Fundus photo
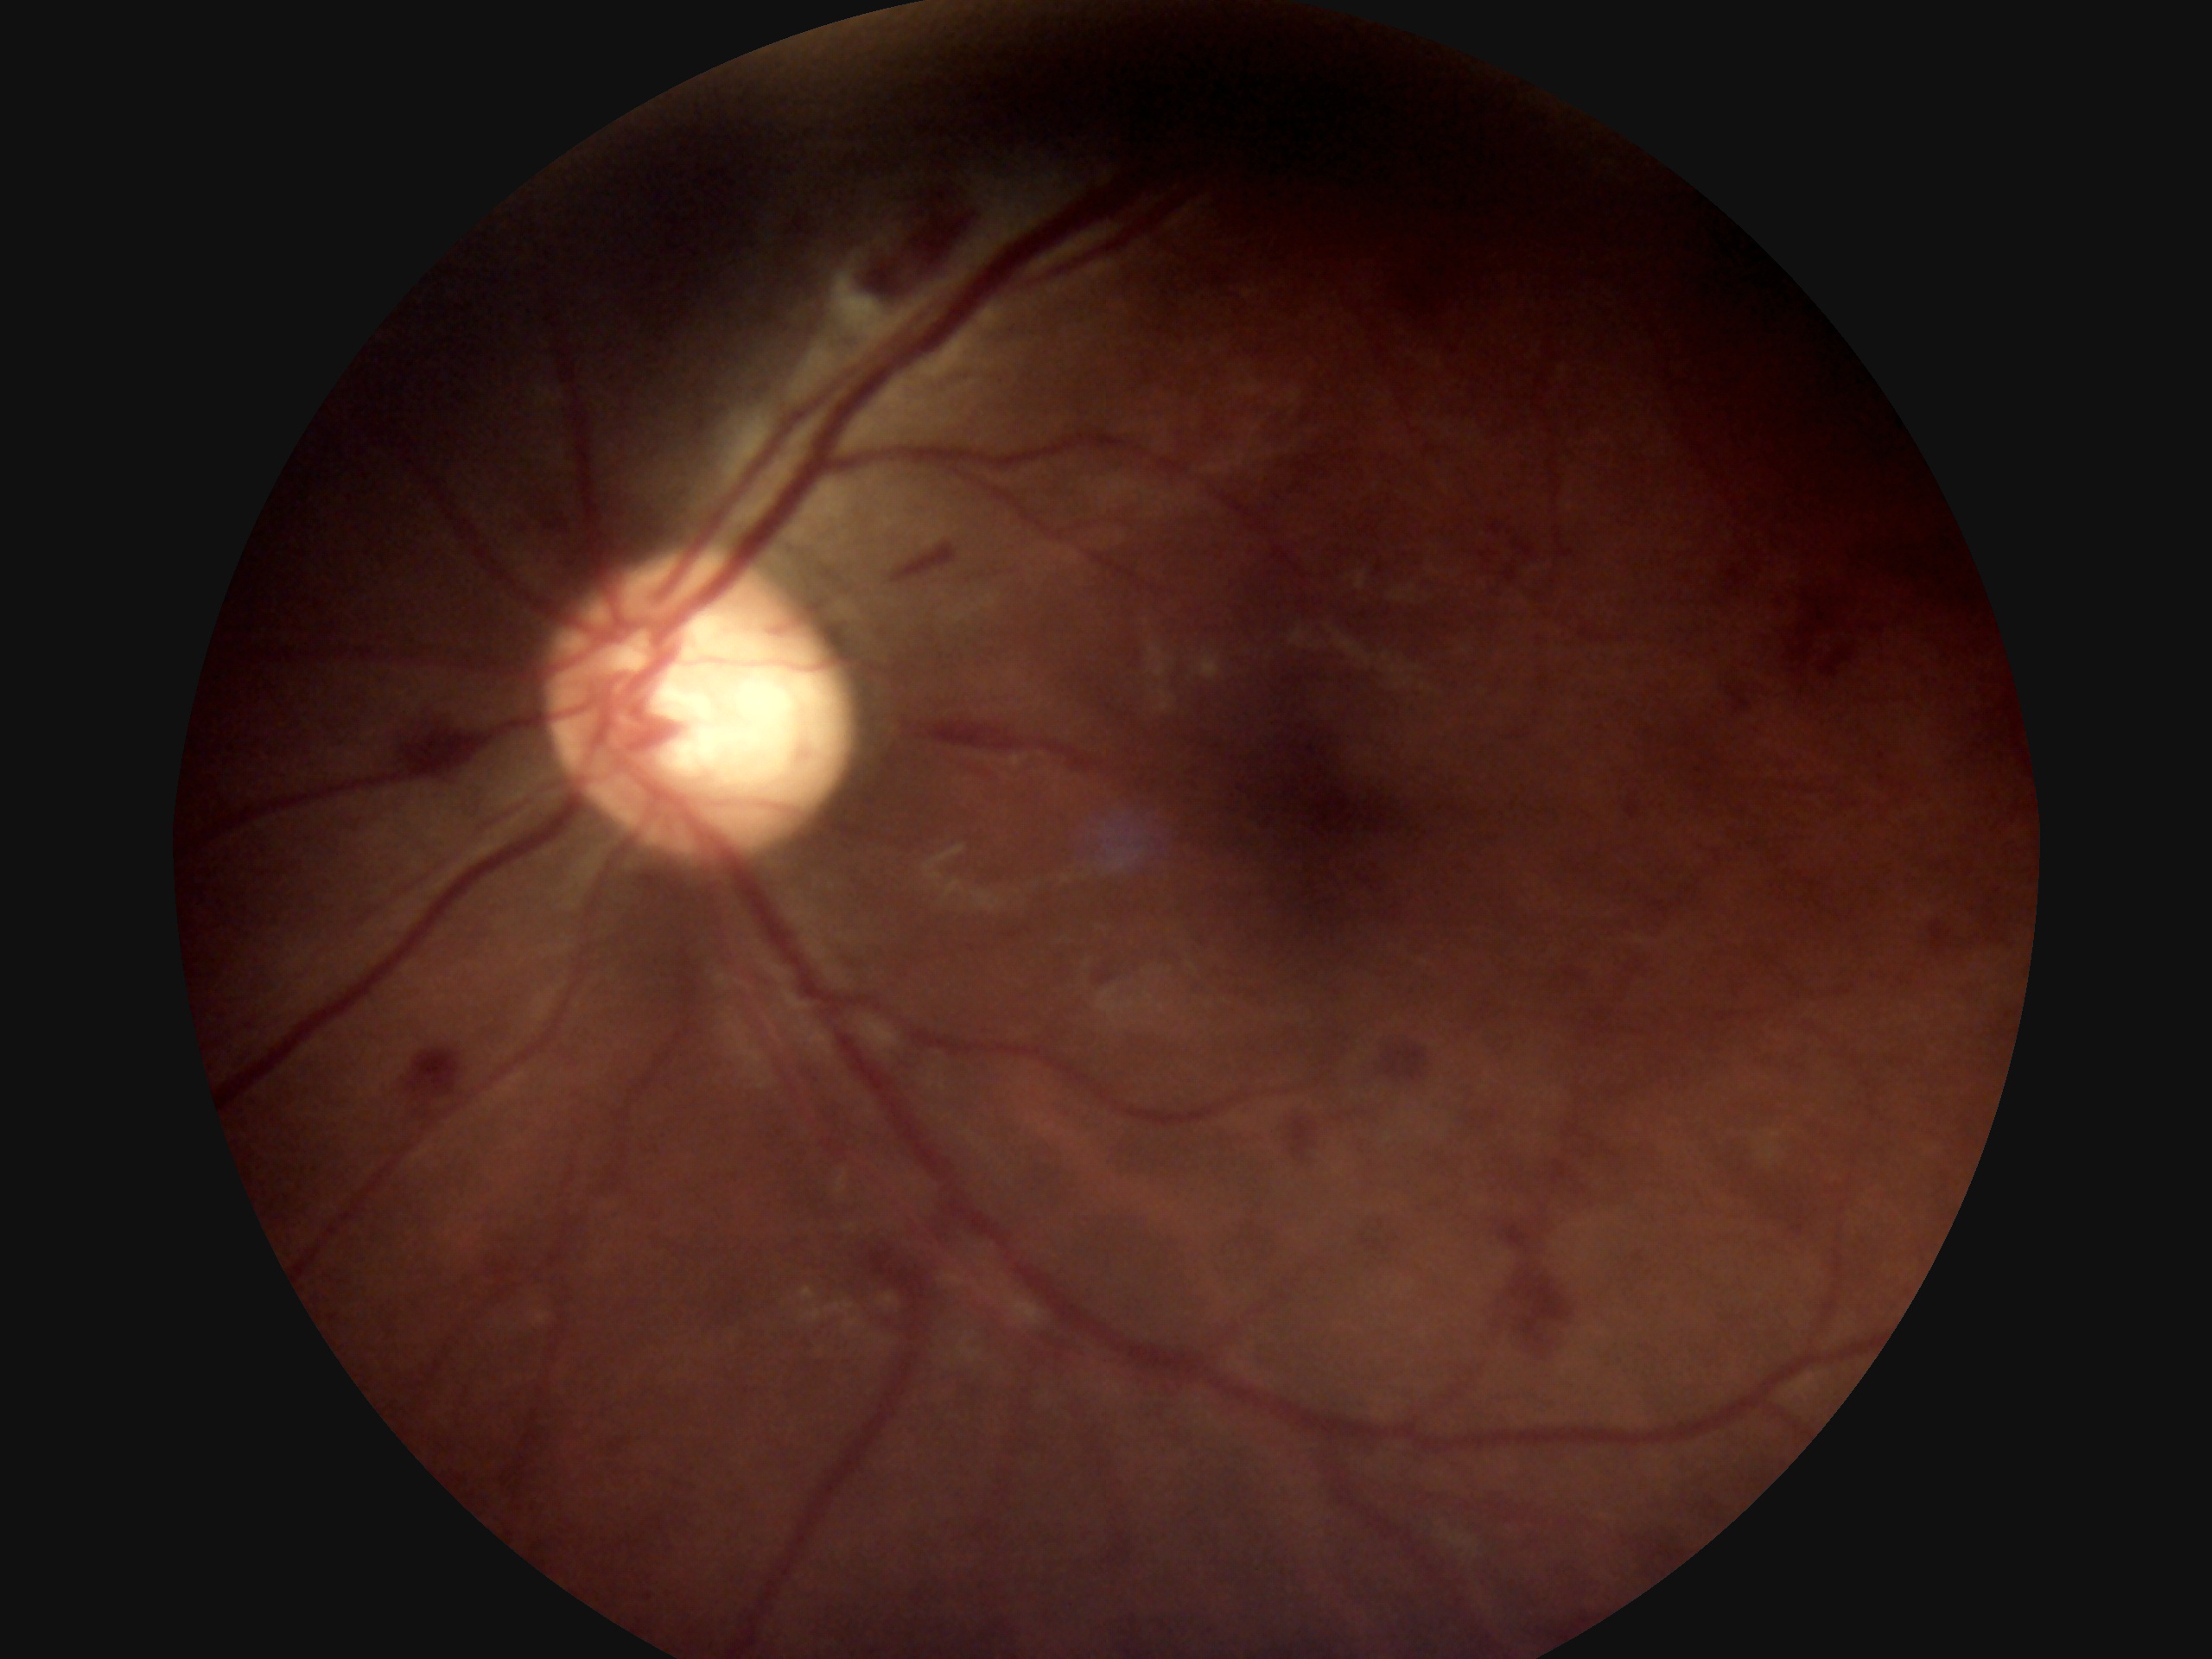
Diabetic retinopathy severity is 2/4.